Color fundus image.
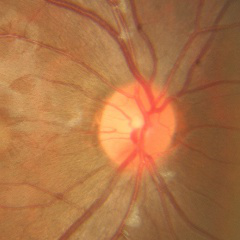

Demonstrates no glaucomatous optic neuropathy.